Color fundus image:
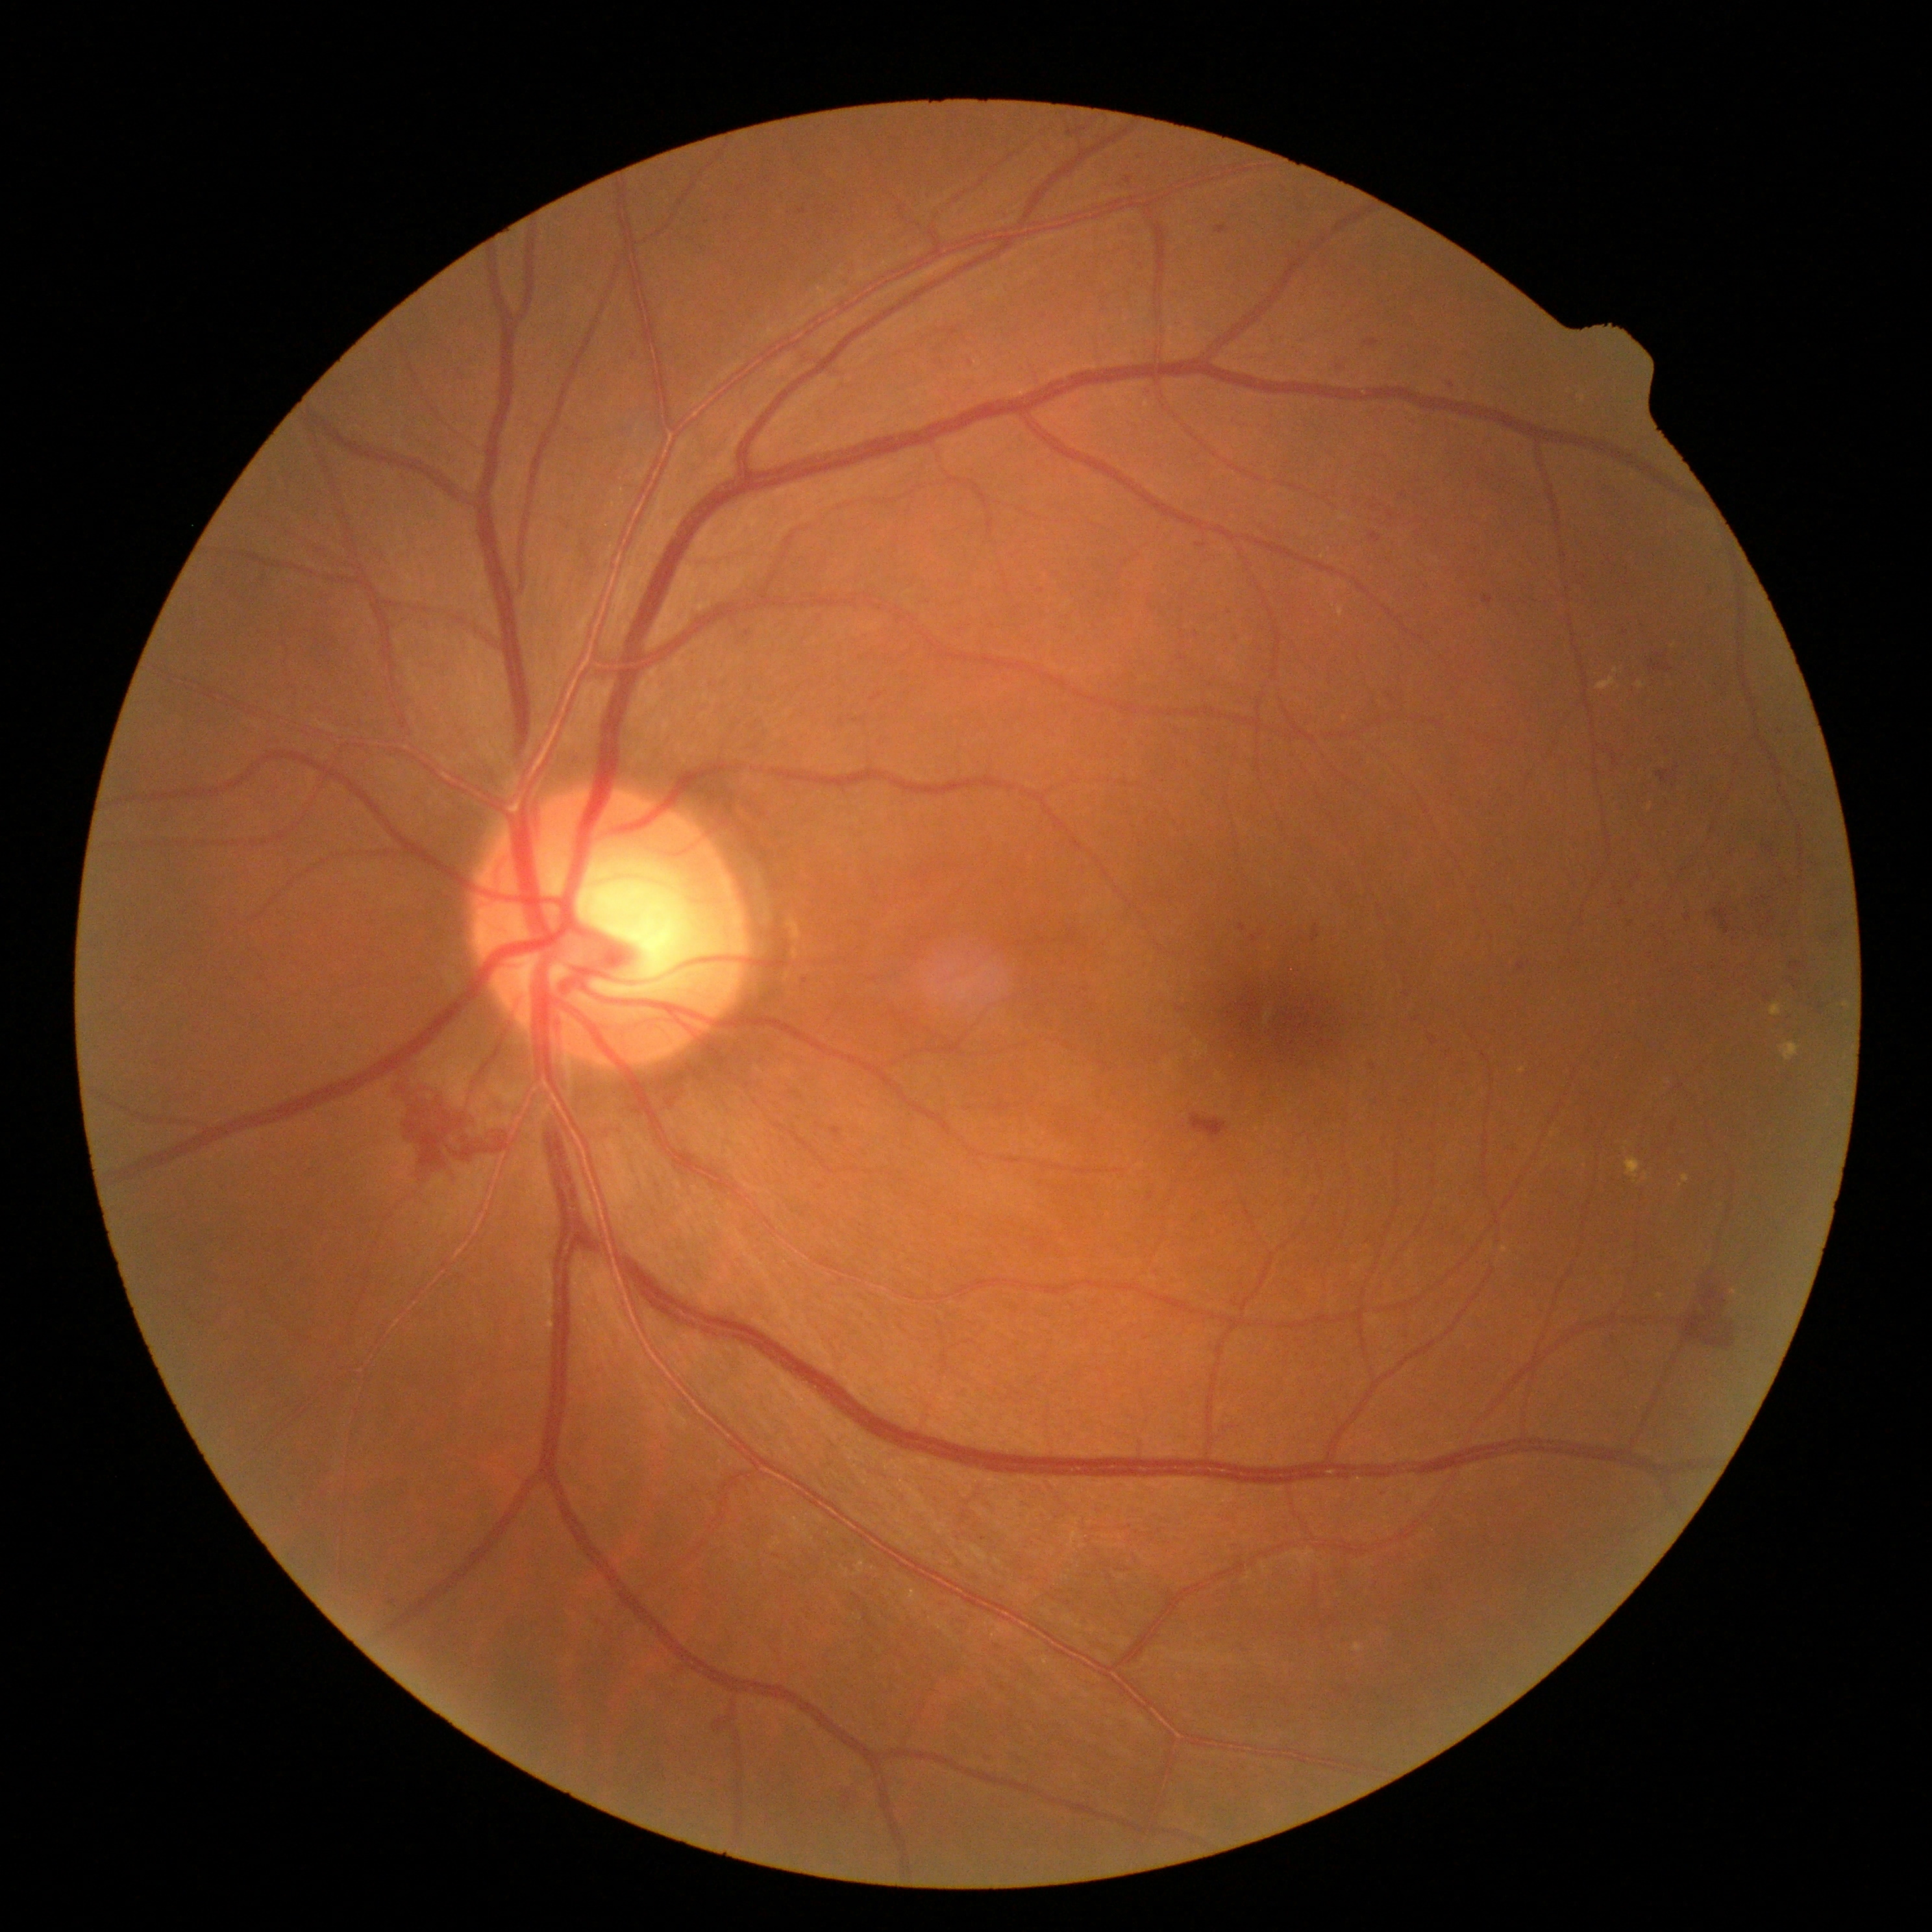
diabetic retinopathy (DR): severe non-proliferative diabetic retinopathy (grade 3); DR class: non-proliferative diabetic retinopathy.